45° FOV, 2048 by 1536 pixels.
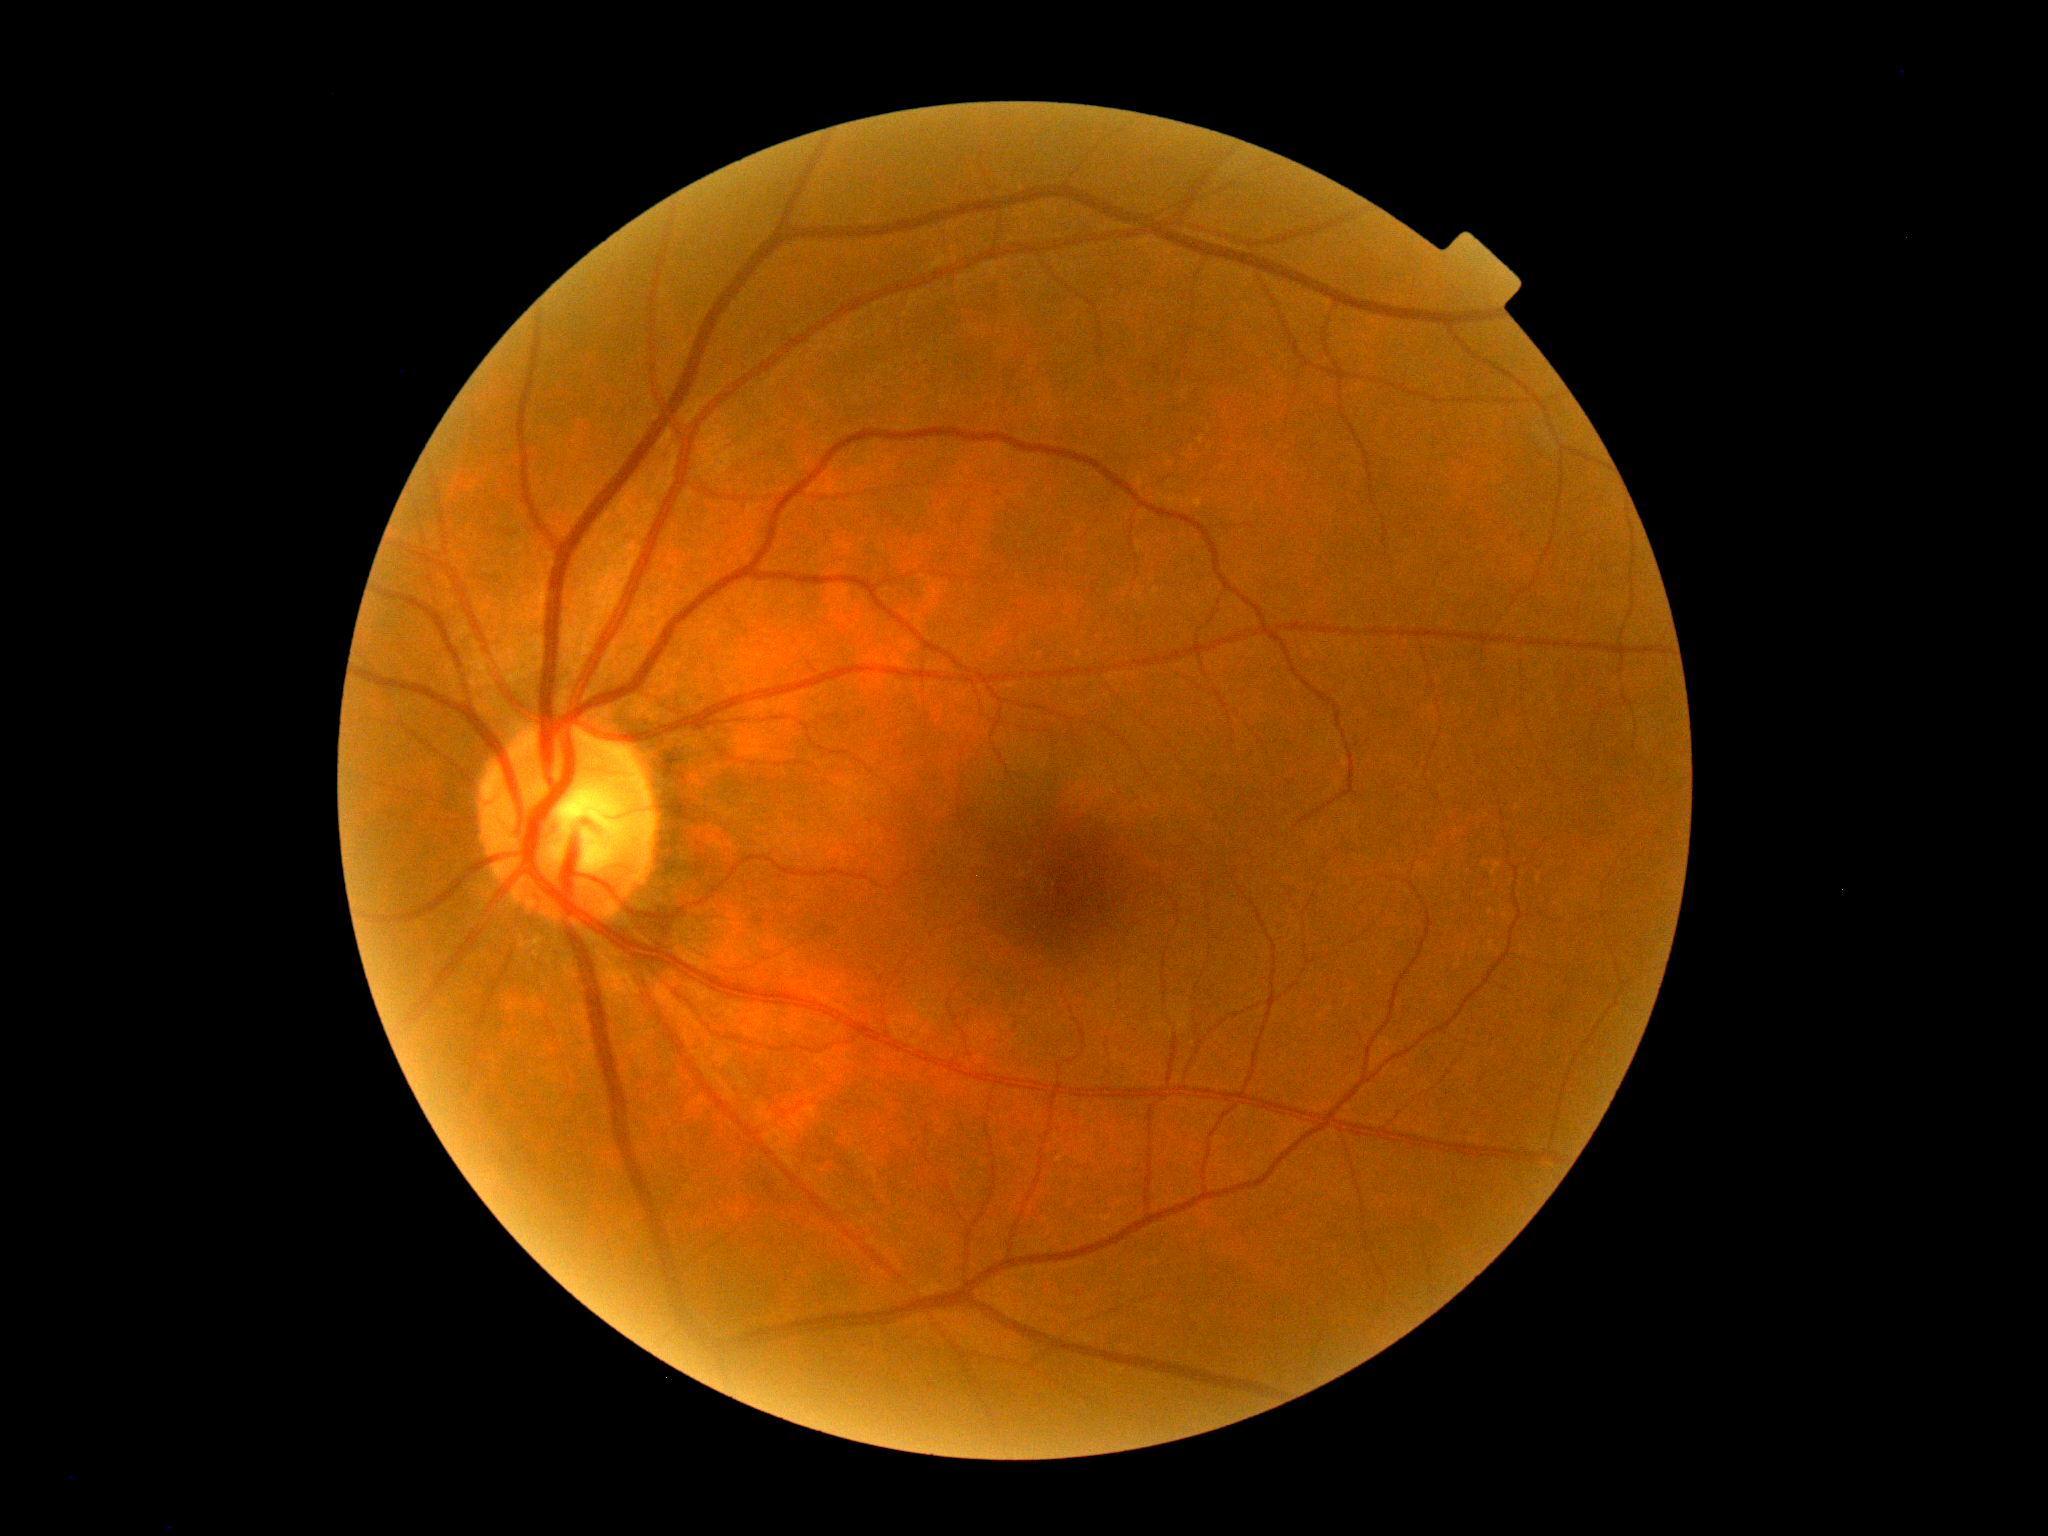 • retinopathy grade: 0
• DR impression: no DR findings